Captured with the Phoenix ICON (100° field of view) · pediatric retinal photograph (wide-field).
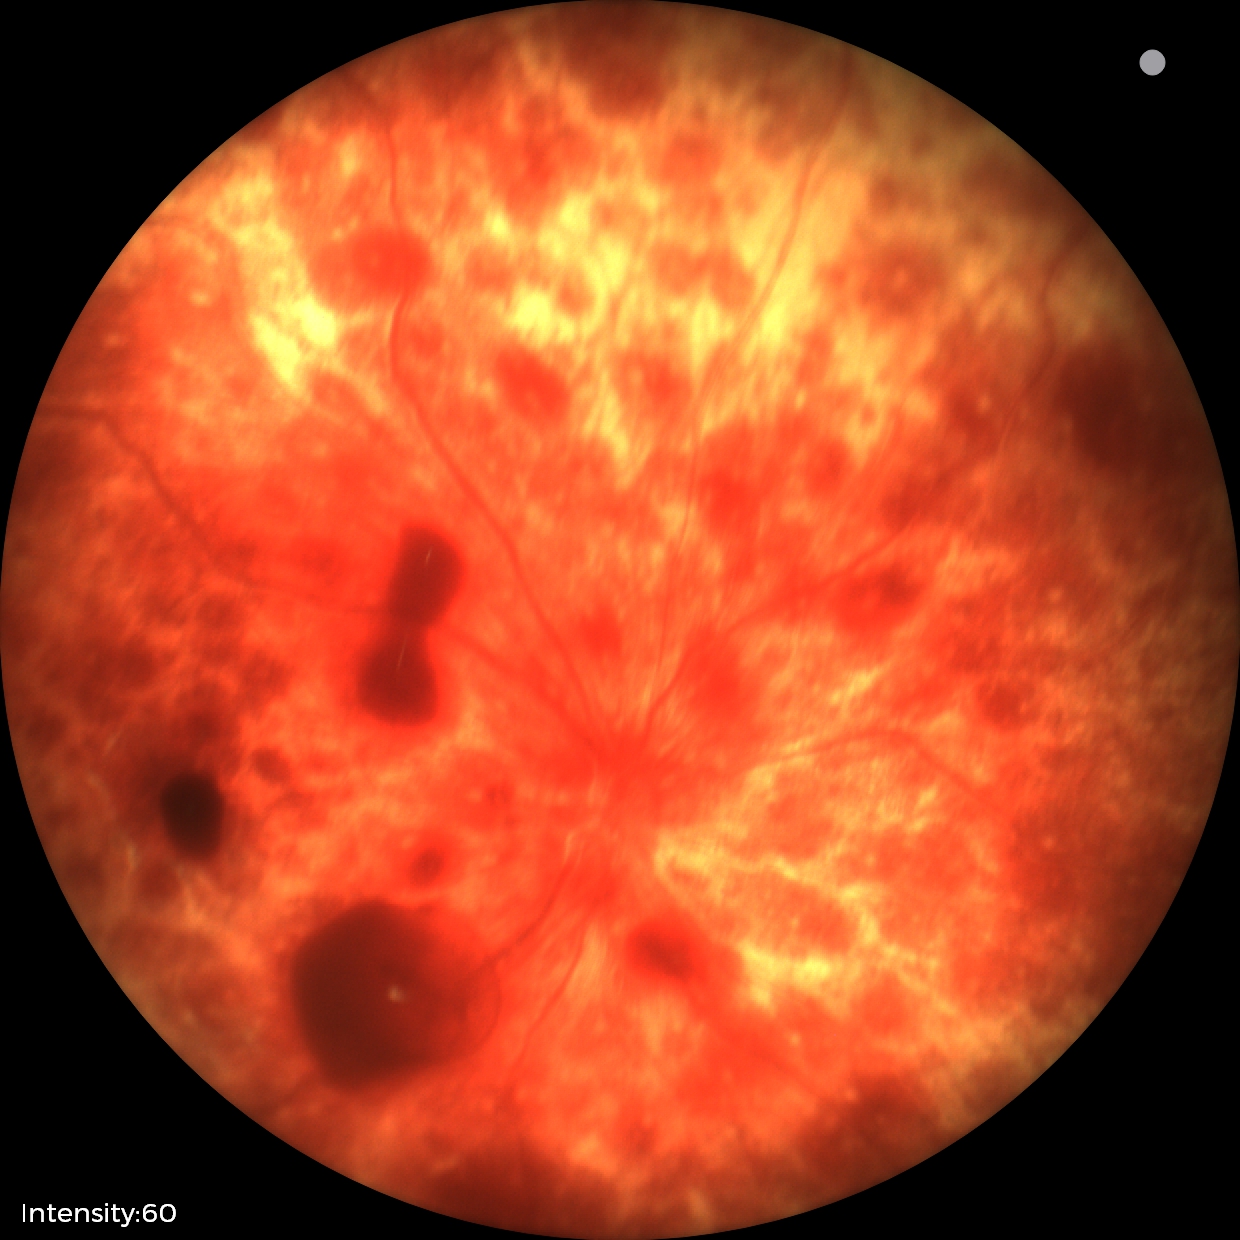 Screening series with retinal hemorrhages.